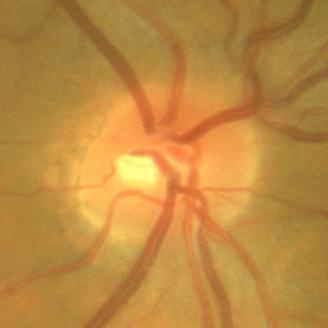 Demonstrates no glaucomatous optic neuropathy.